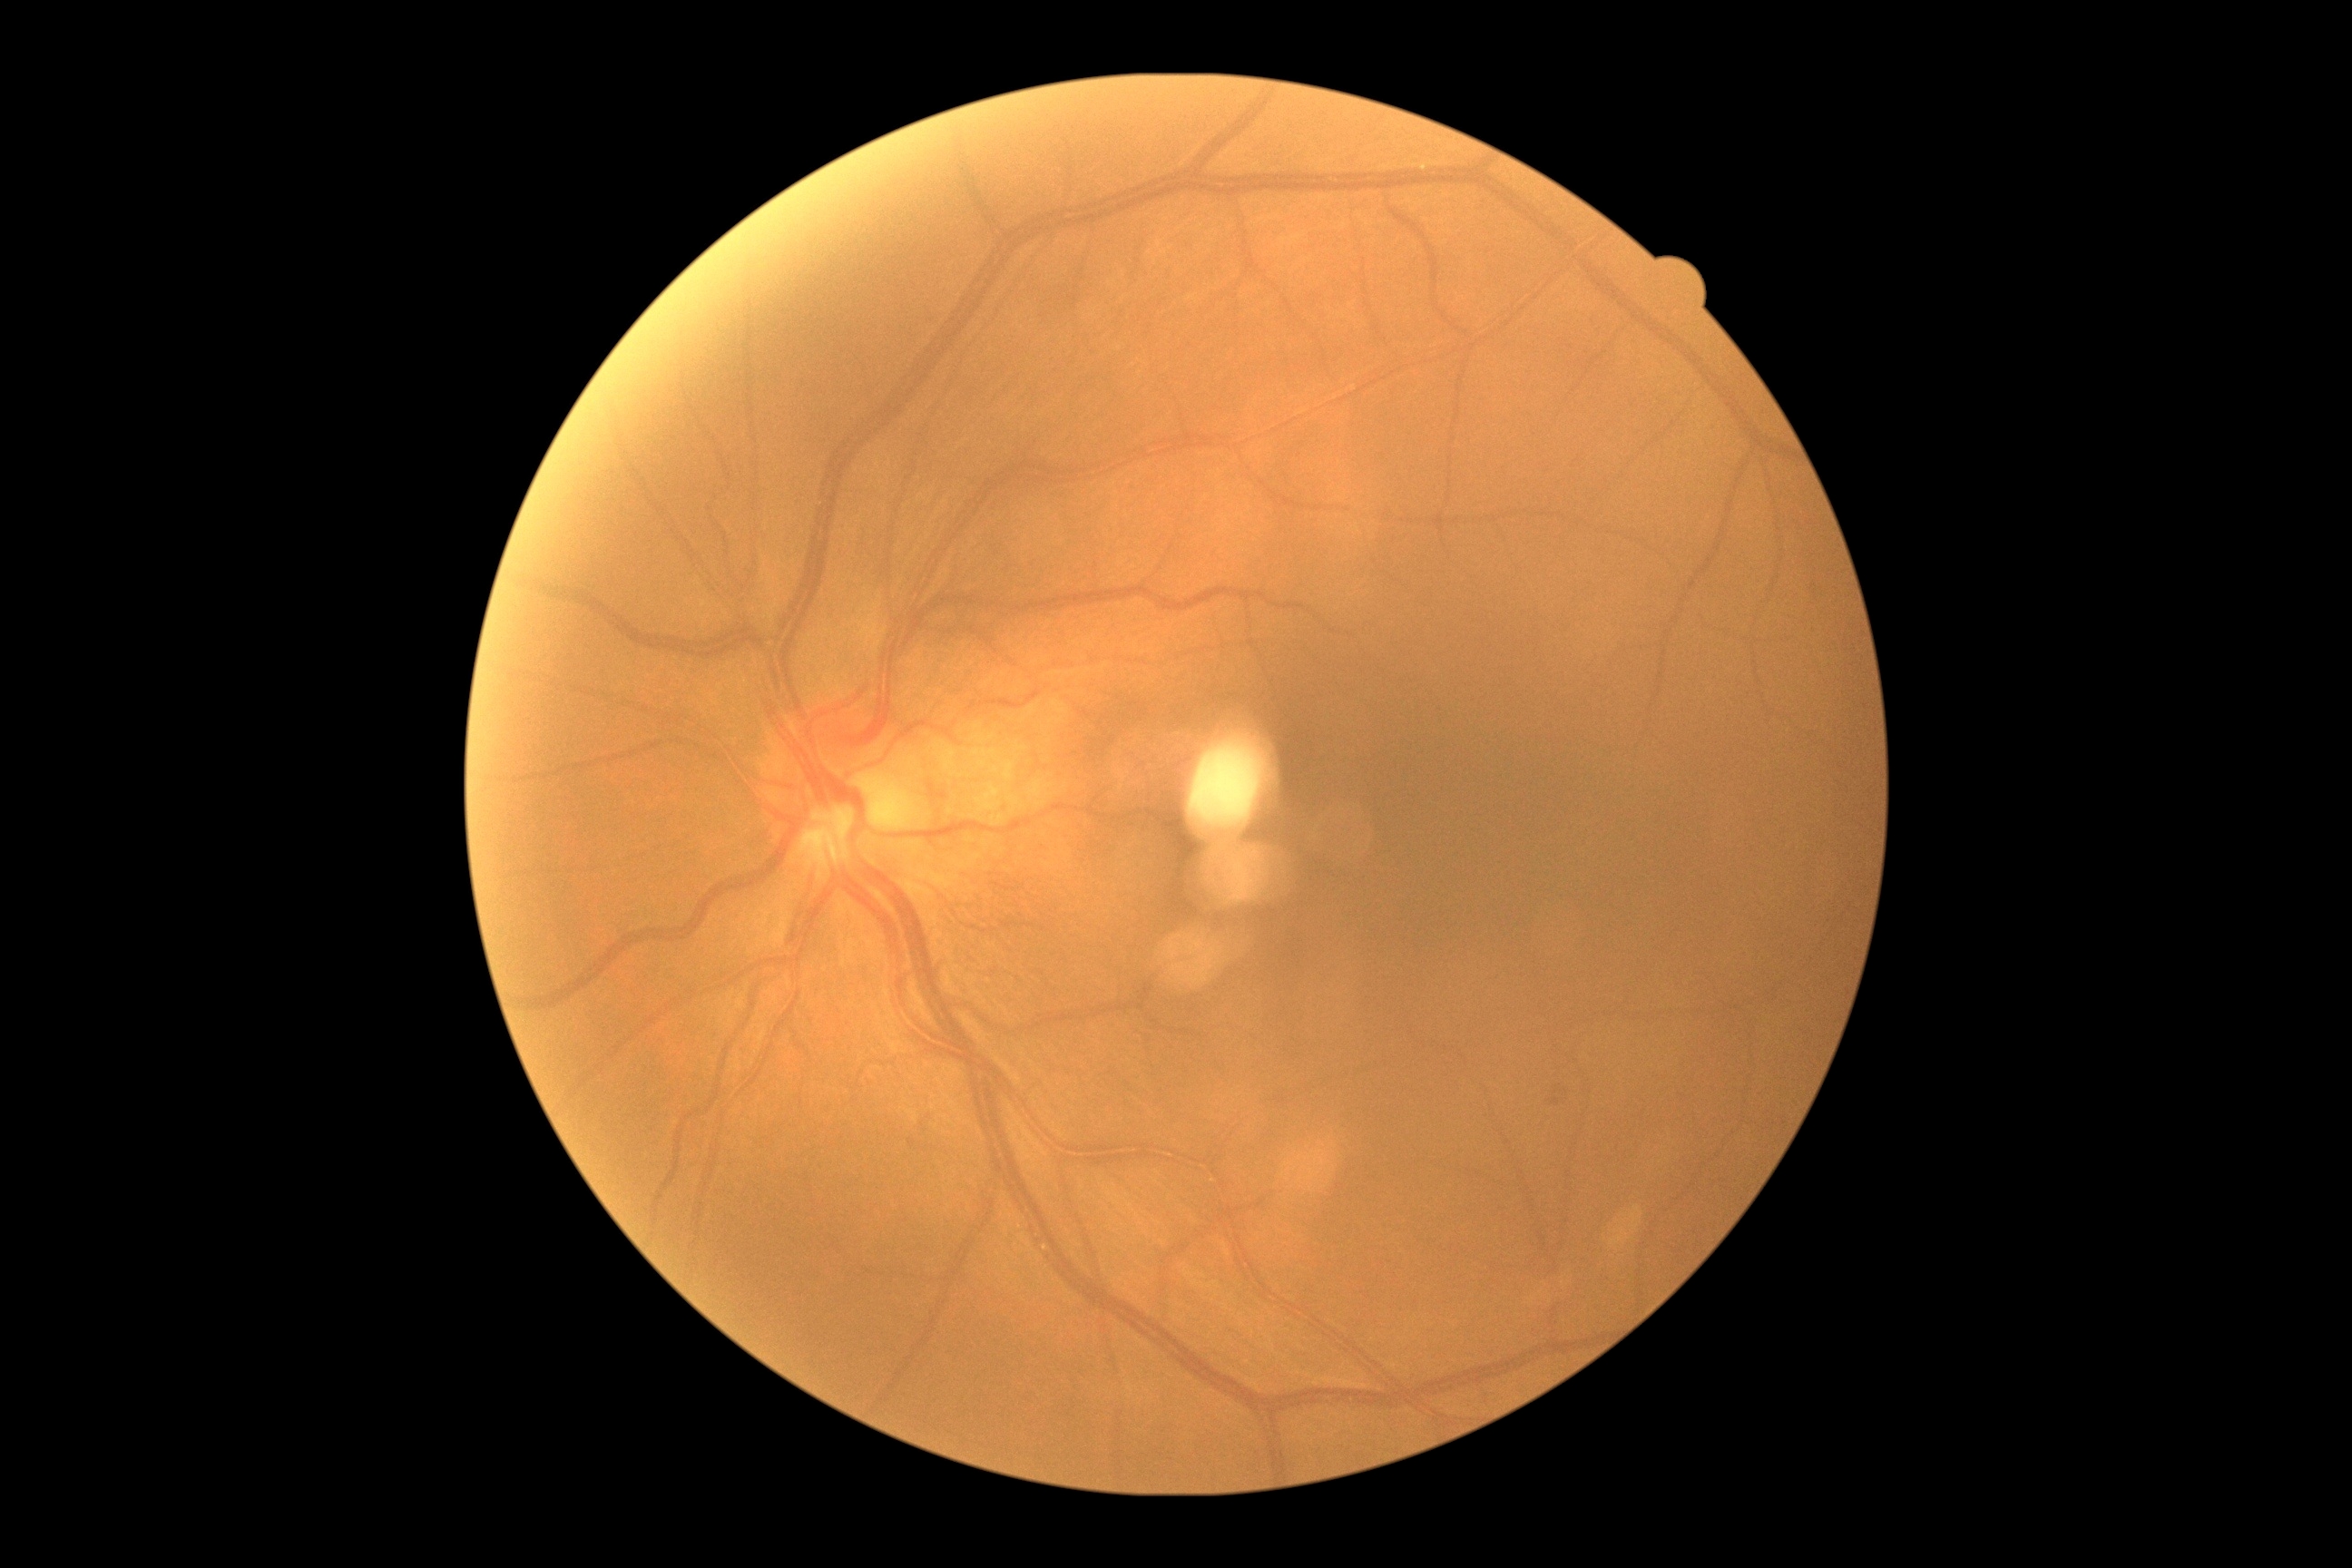

Diabetic retinopathy severity is 0. No diabetic retinal disease findings.